Clarity RetCam 3, 130° FOV · infant wide-field retinal image: 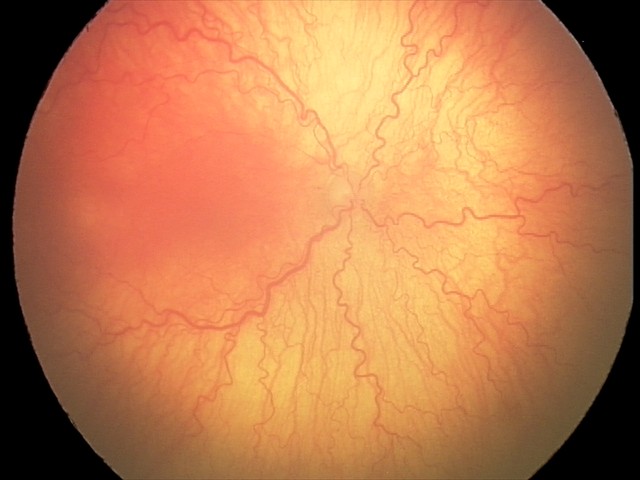
Assessment = aggressive retinopathy of prematurity
plus disease = present